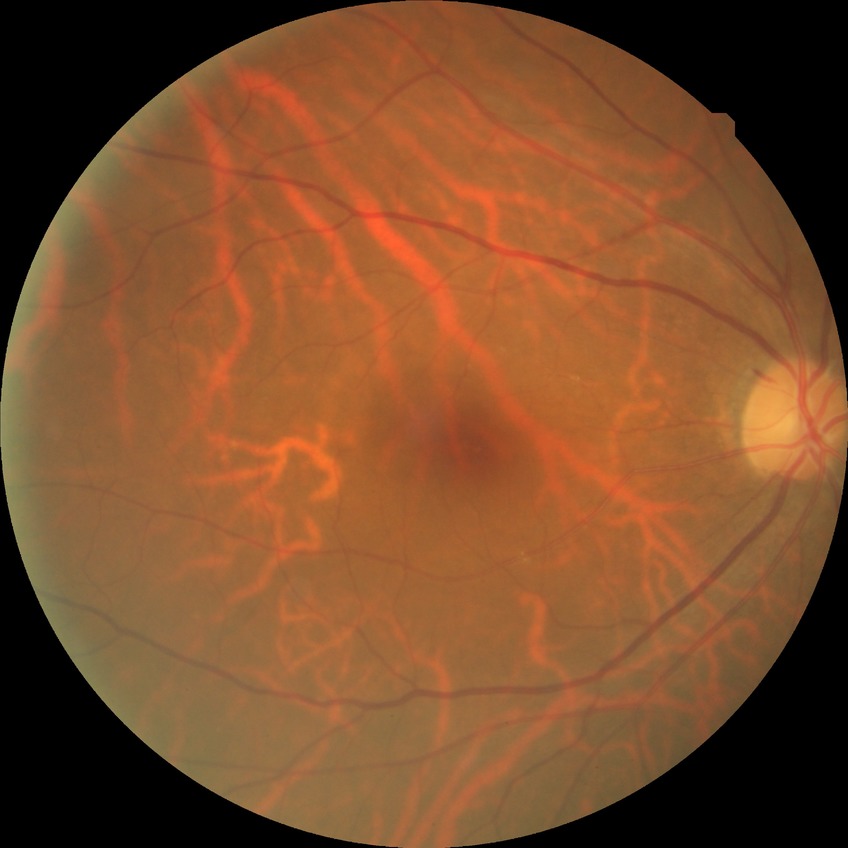

diabetic retinopathy stage = simple diabetic retinopathy.